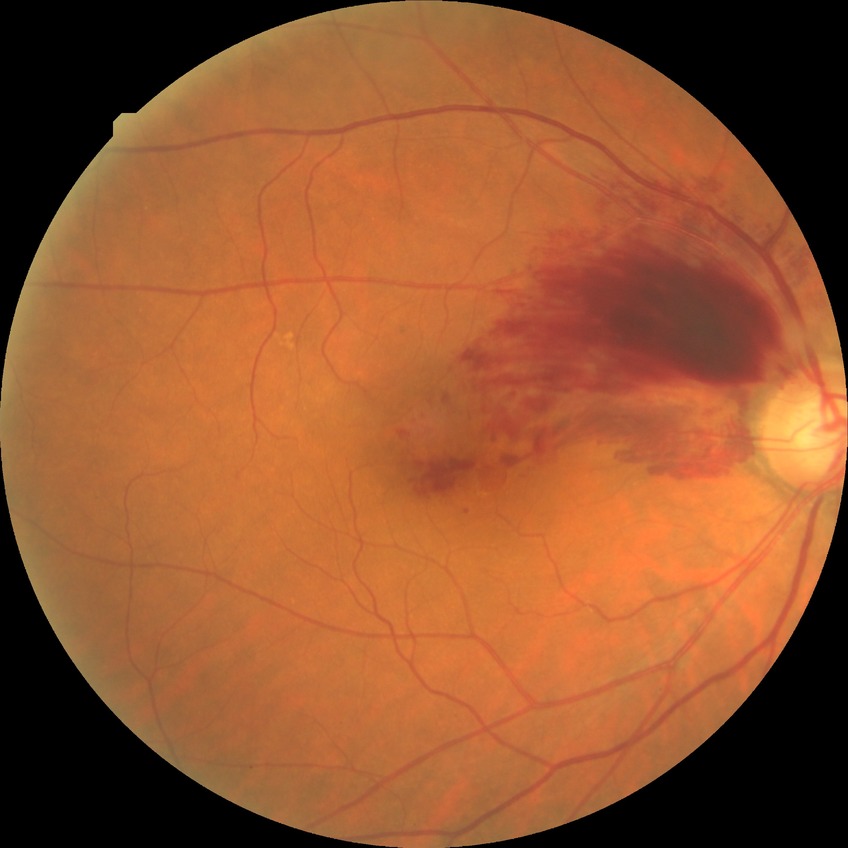

{
  "dr_impression": "no DR findings",
  "davis_grade": "NDR"
}